No pharmacologic dilation. Modified Davis classification
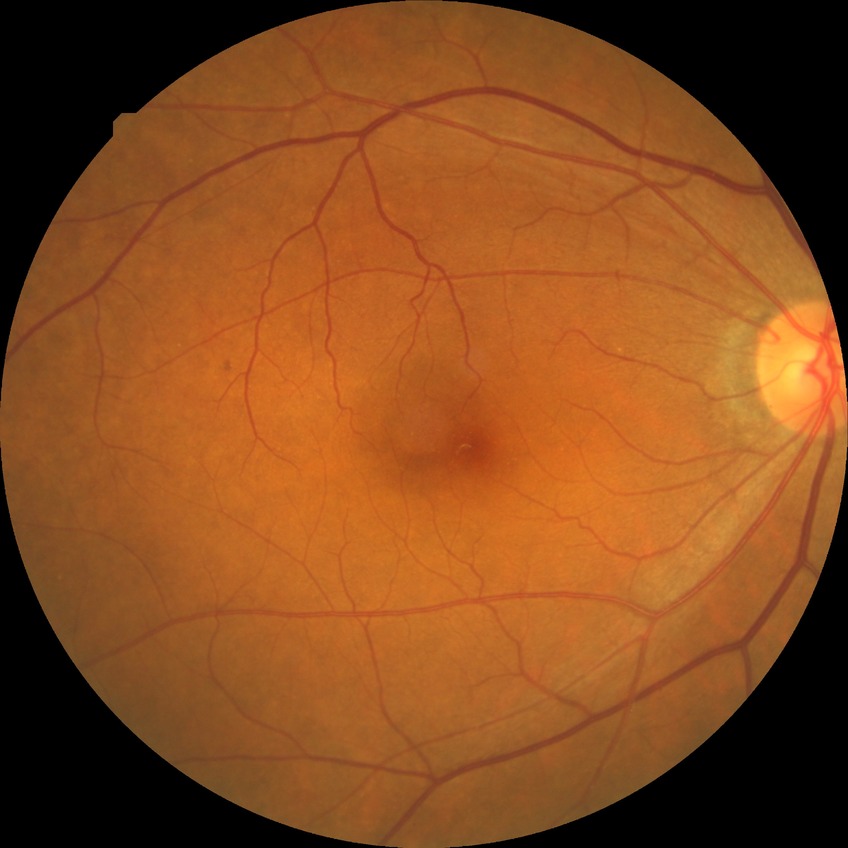 diabetic retinopathy (DR) = no diabetic retinopathy (NDR).